640 x 480 pixels · Clarity RetCam 3, 130° FOV · wide-field fundus image from infant ROP screening
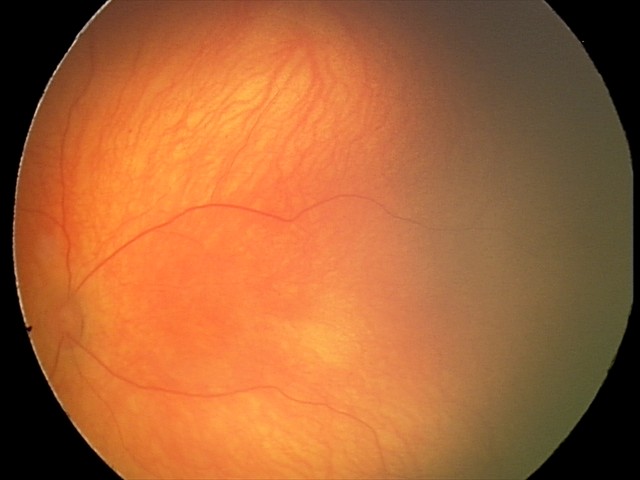 Screening examination with no abnormal retinal findings.